UWF retinal mosaic.
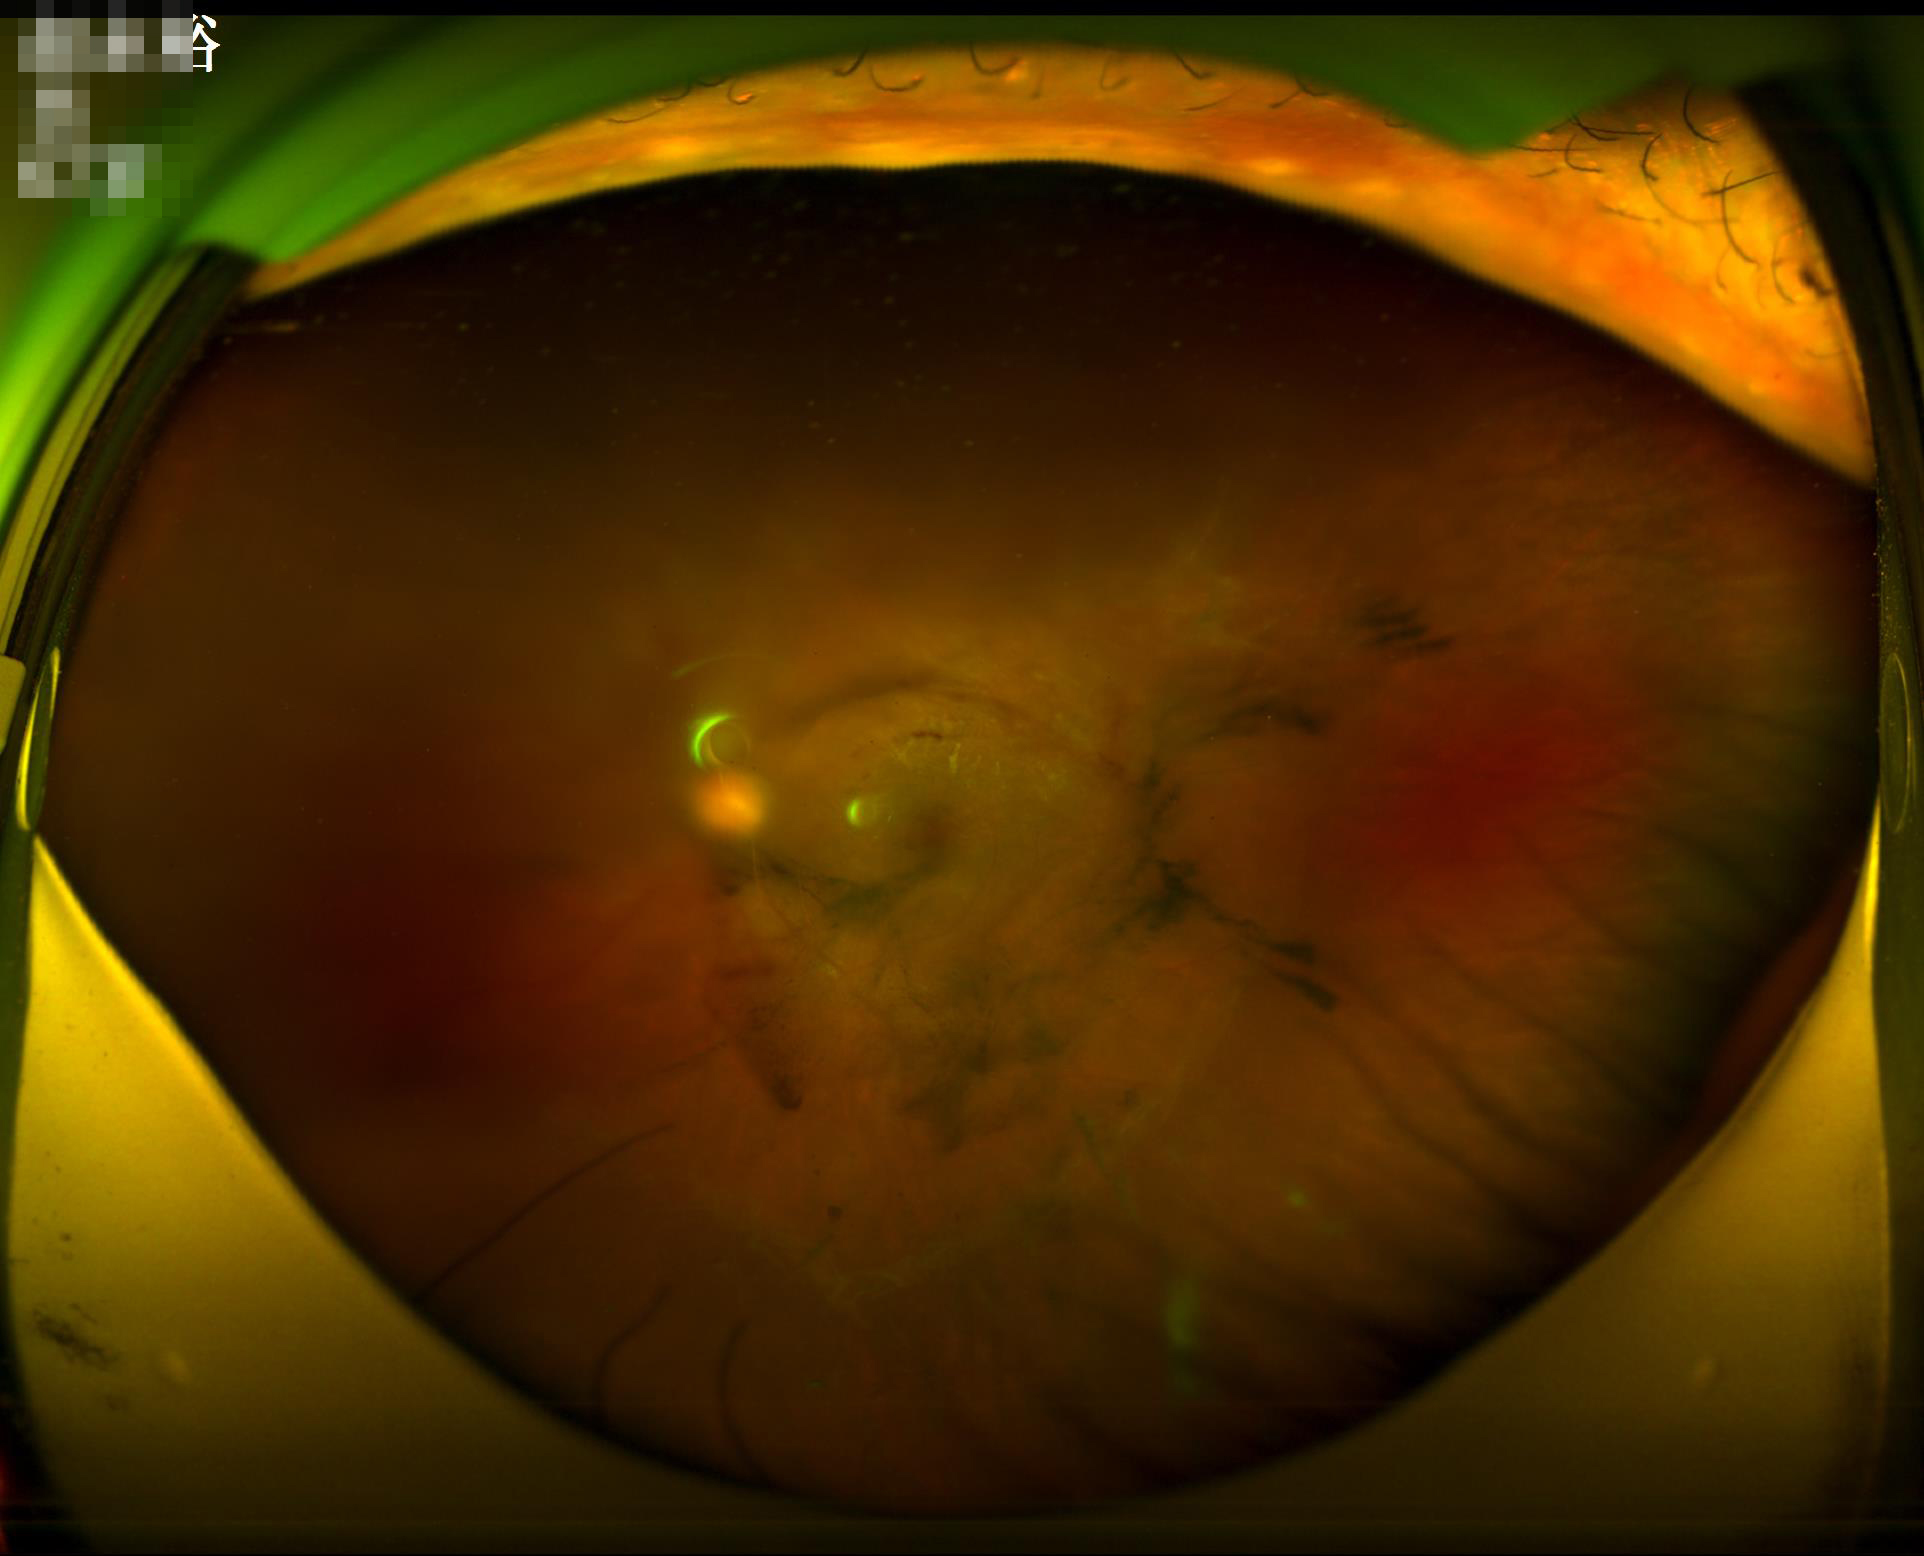

Reduced sharpness with visible blur.
Poor dynamic range.
Illumination and color are suboptimal.
Overall quality is poor; the image is difficult to grade.